Image size 2212x1659; 45° FOV
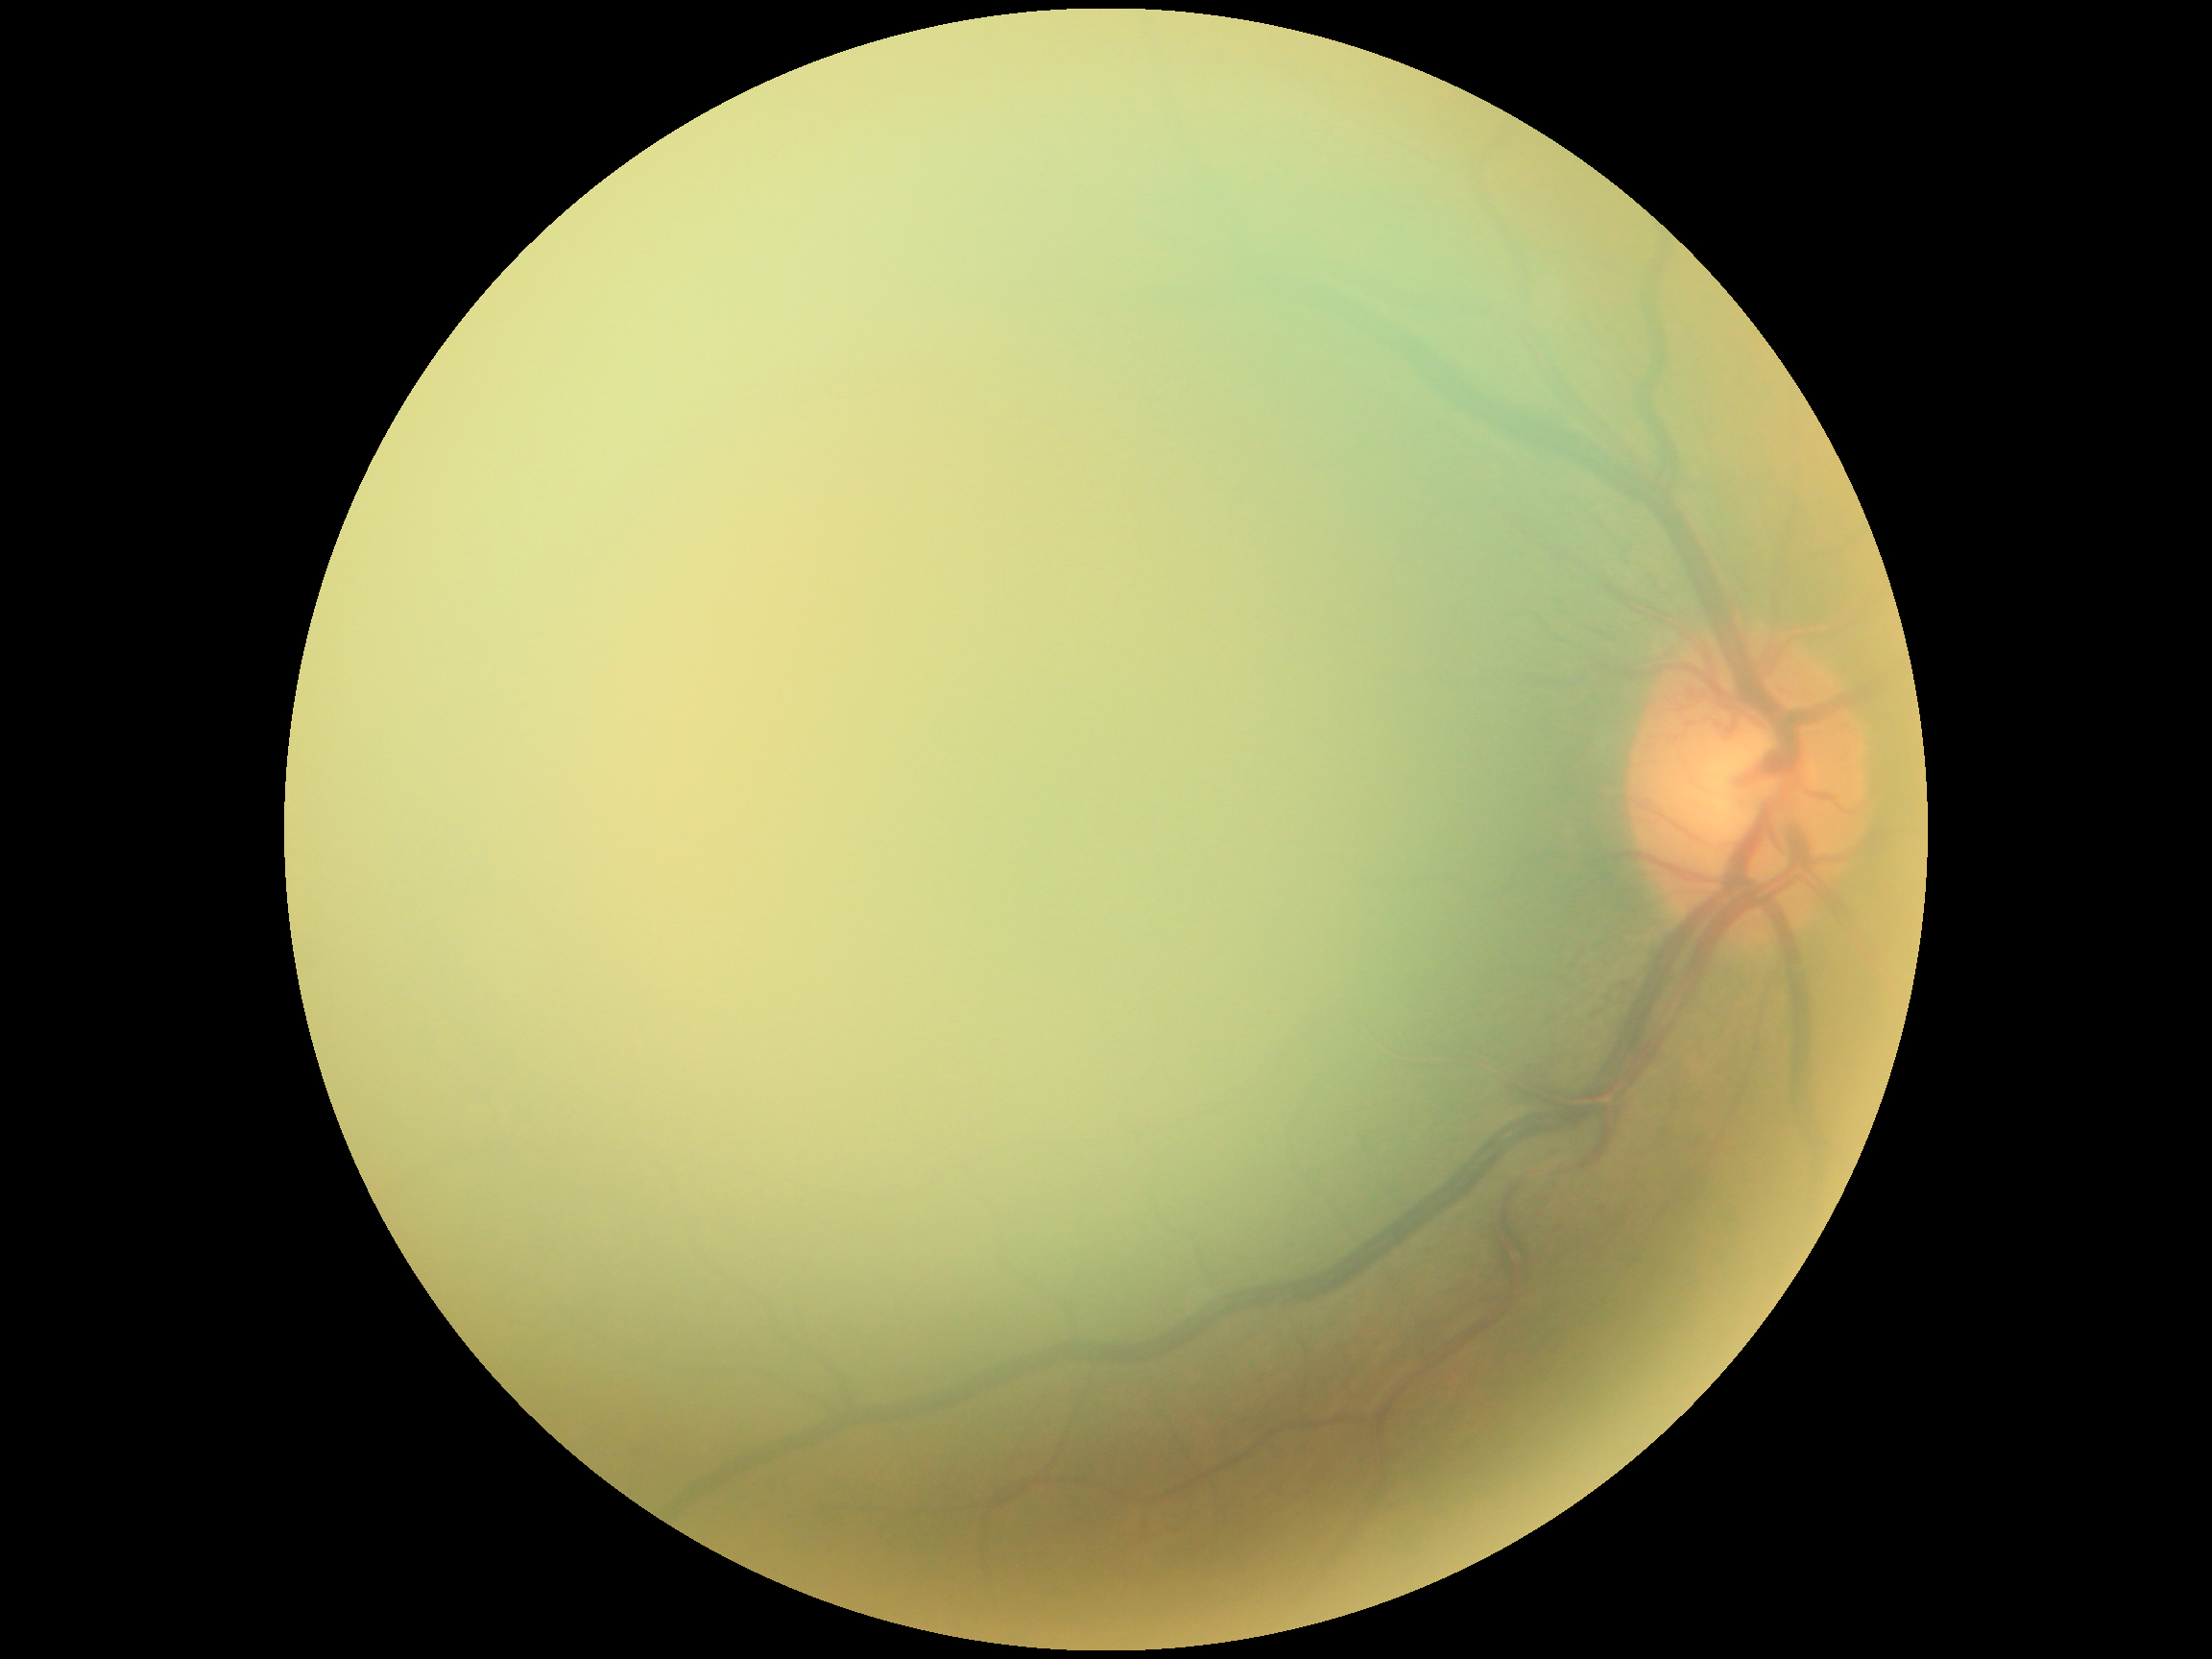 Annotations:
• diabetic retinopathy — ungradable